45° FOV. Image size 2352x1568. Color fundus image
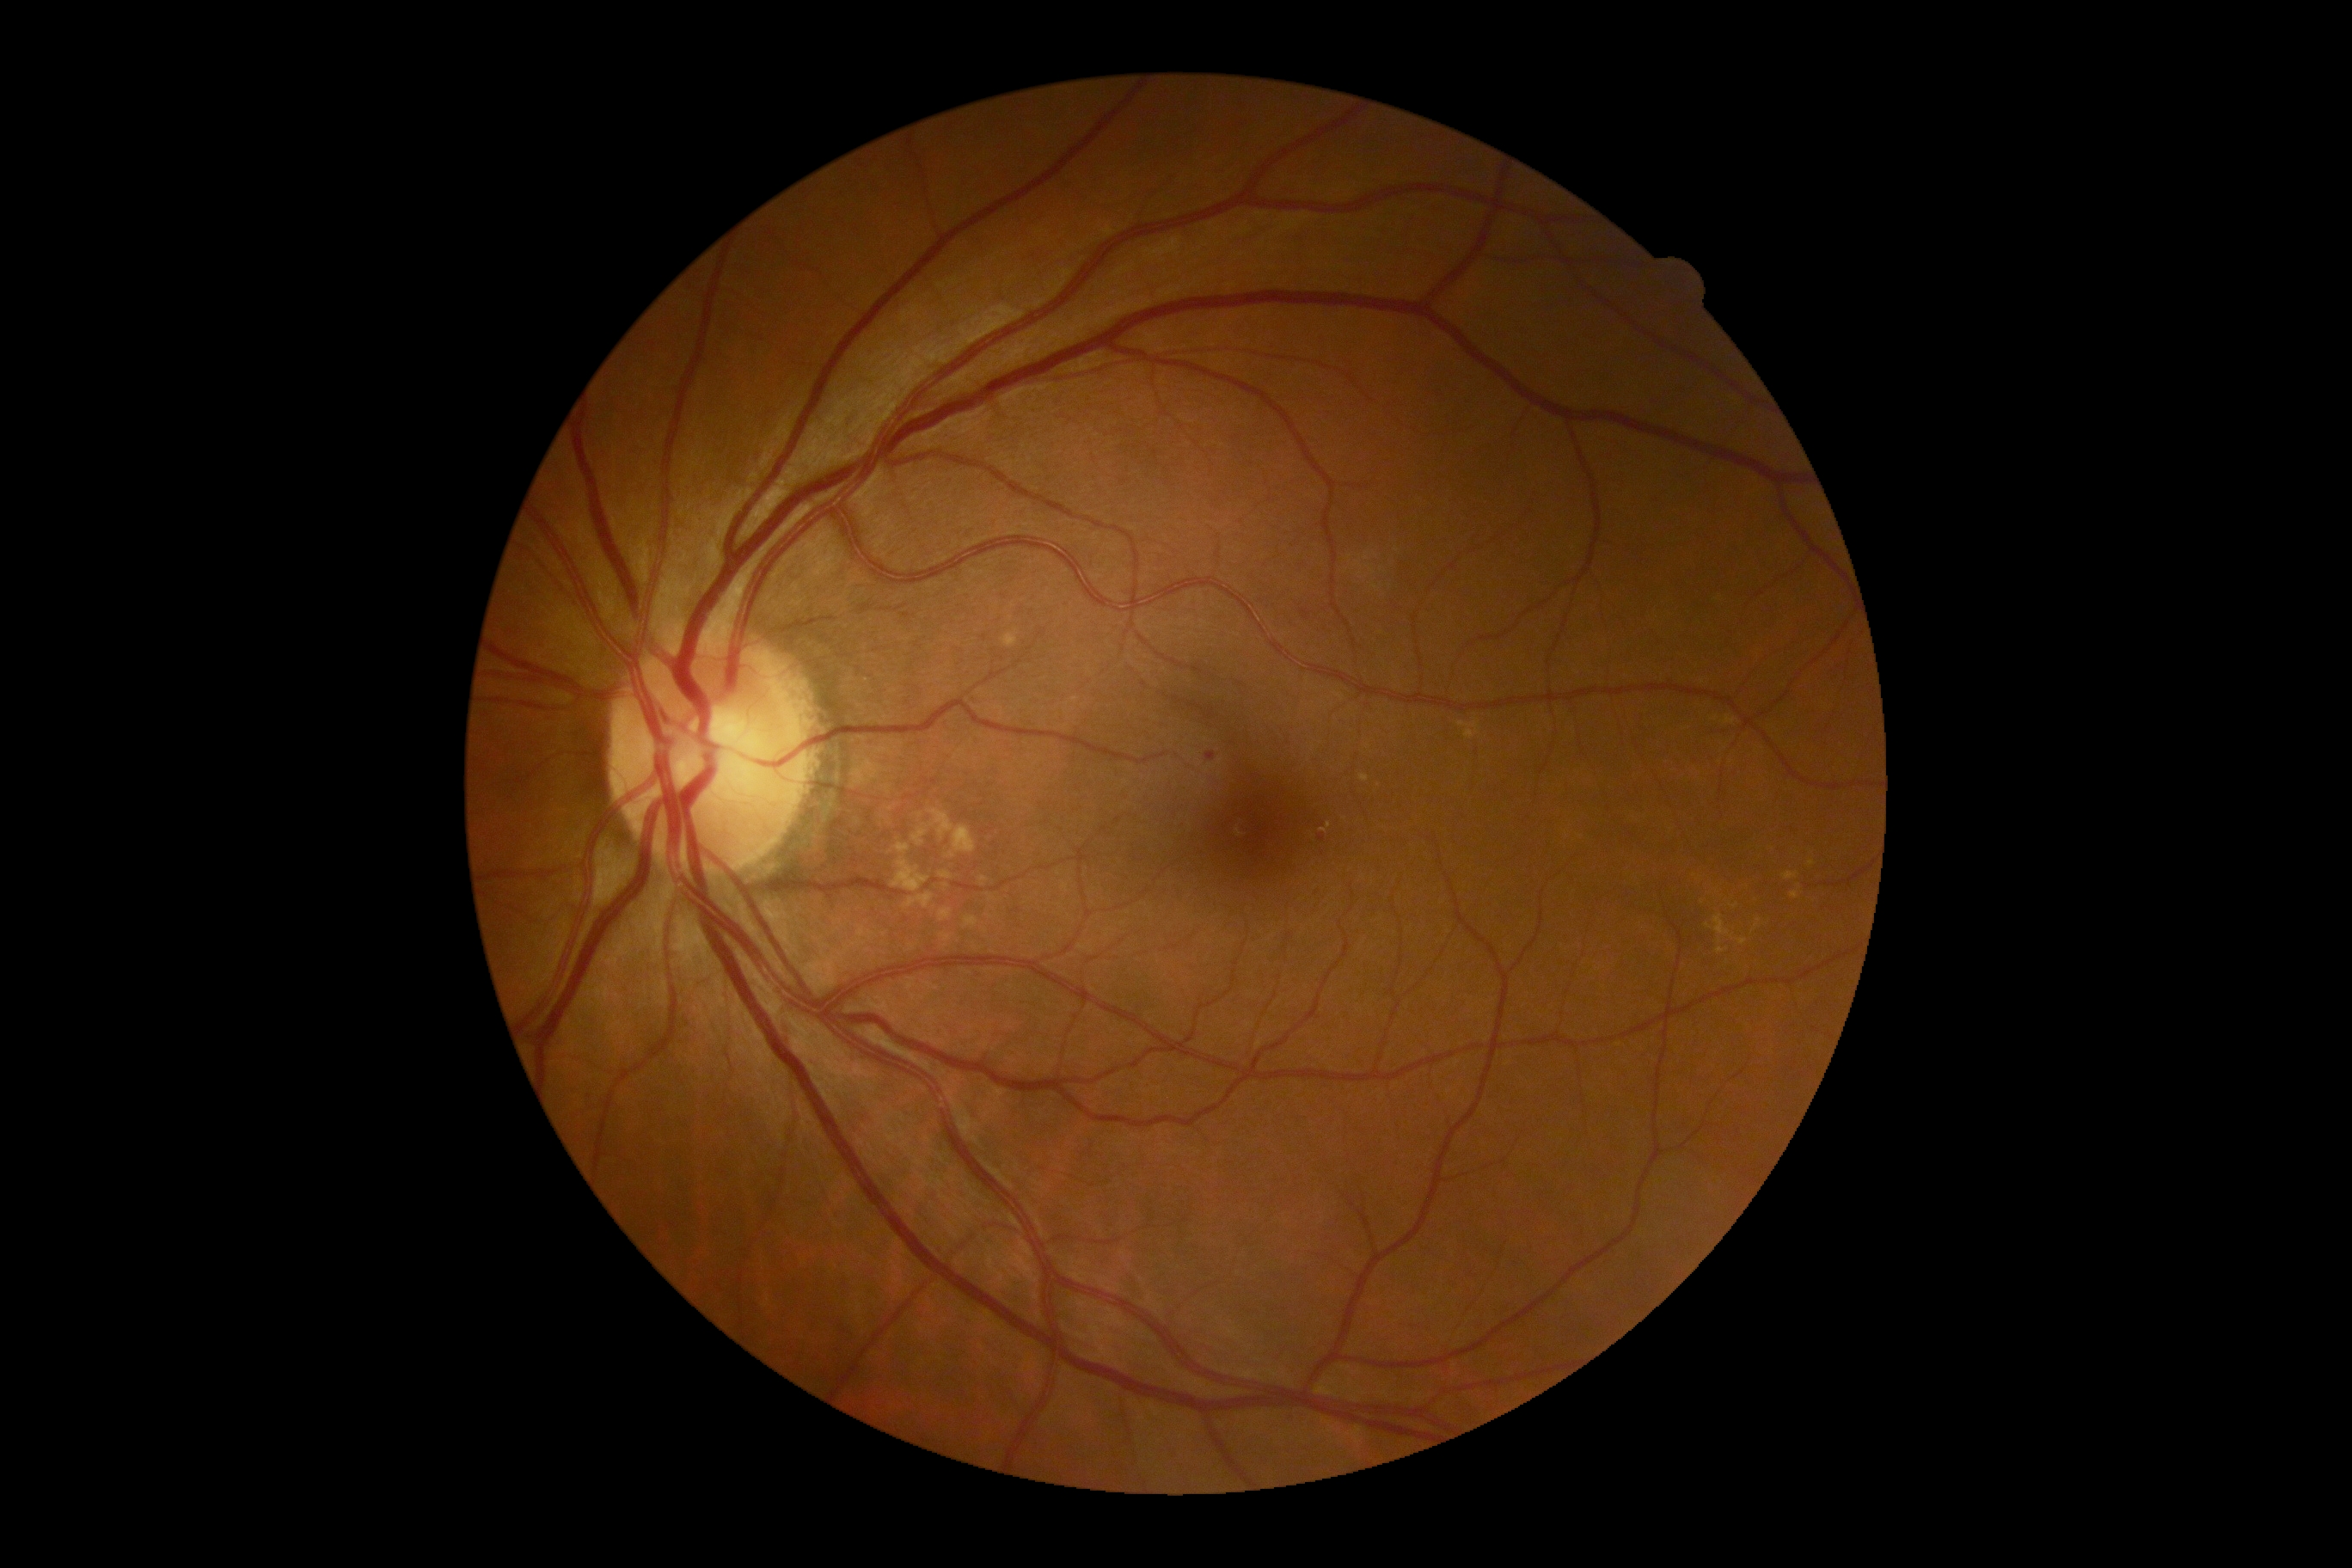
Diabetic retinopathy (DR): grade 2 (moderate NPDR).